Retinal fundus photograph; 240 x 240 pixels: 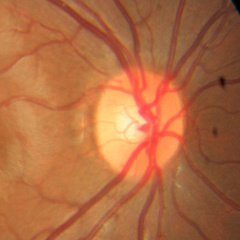

Glaucoma status = no signs of glaucoma.